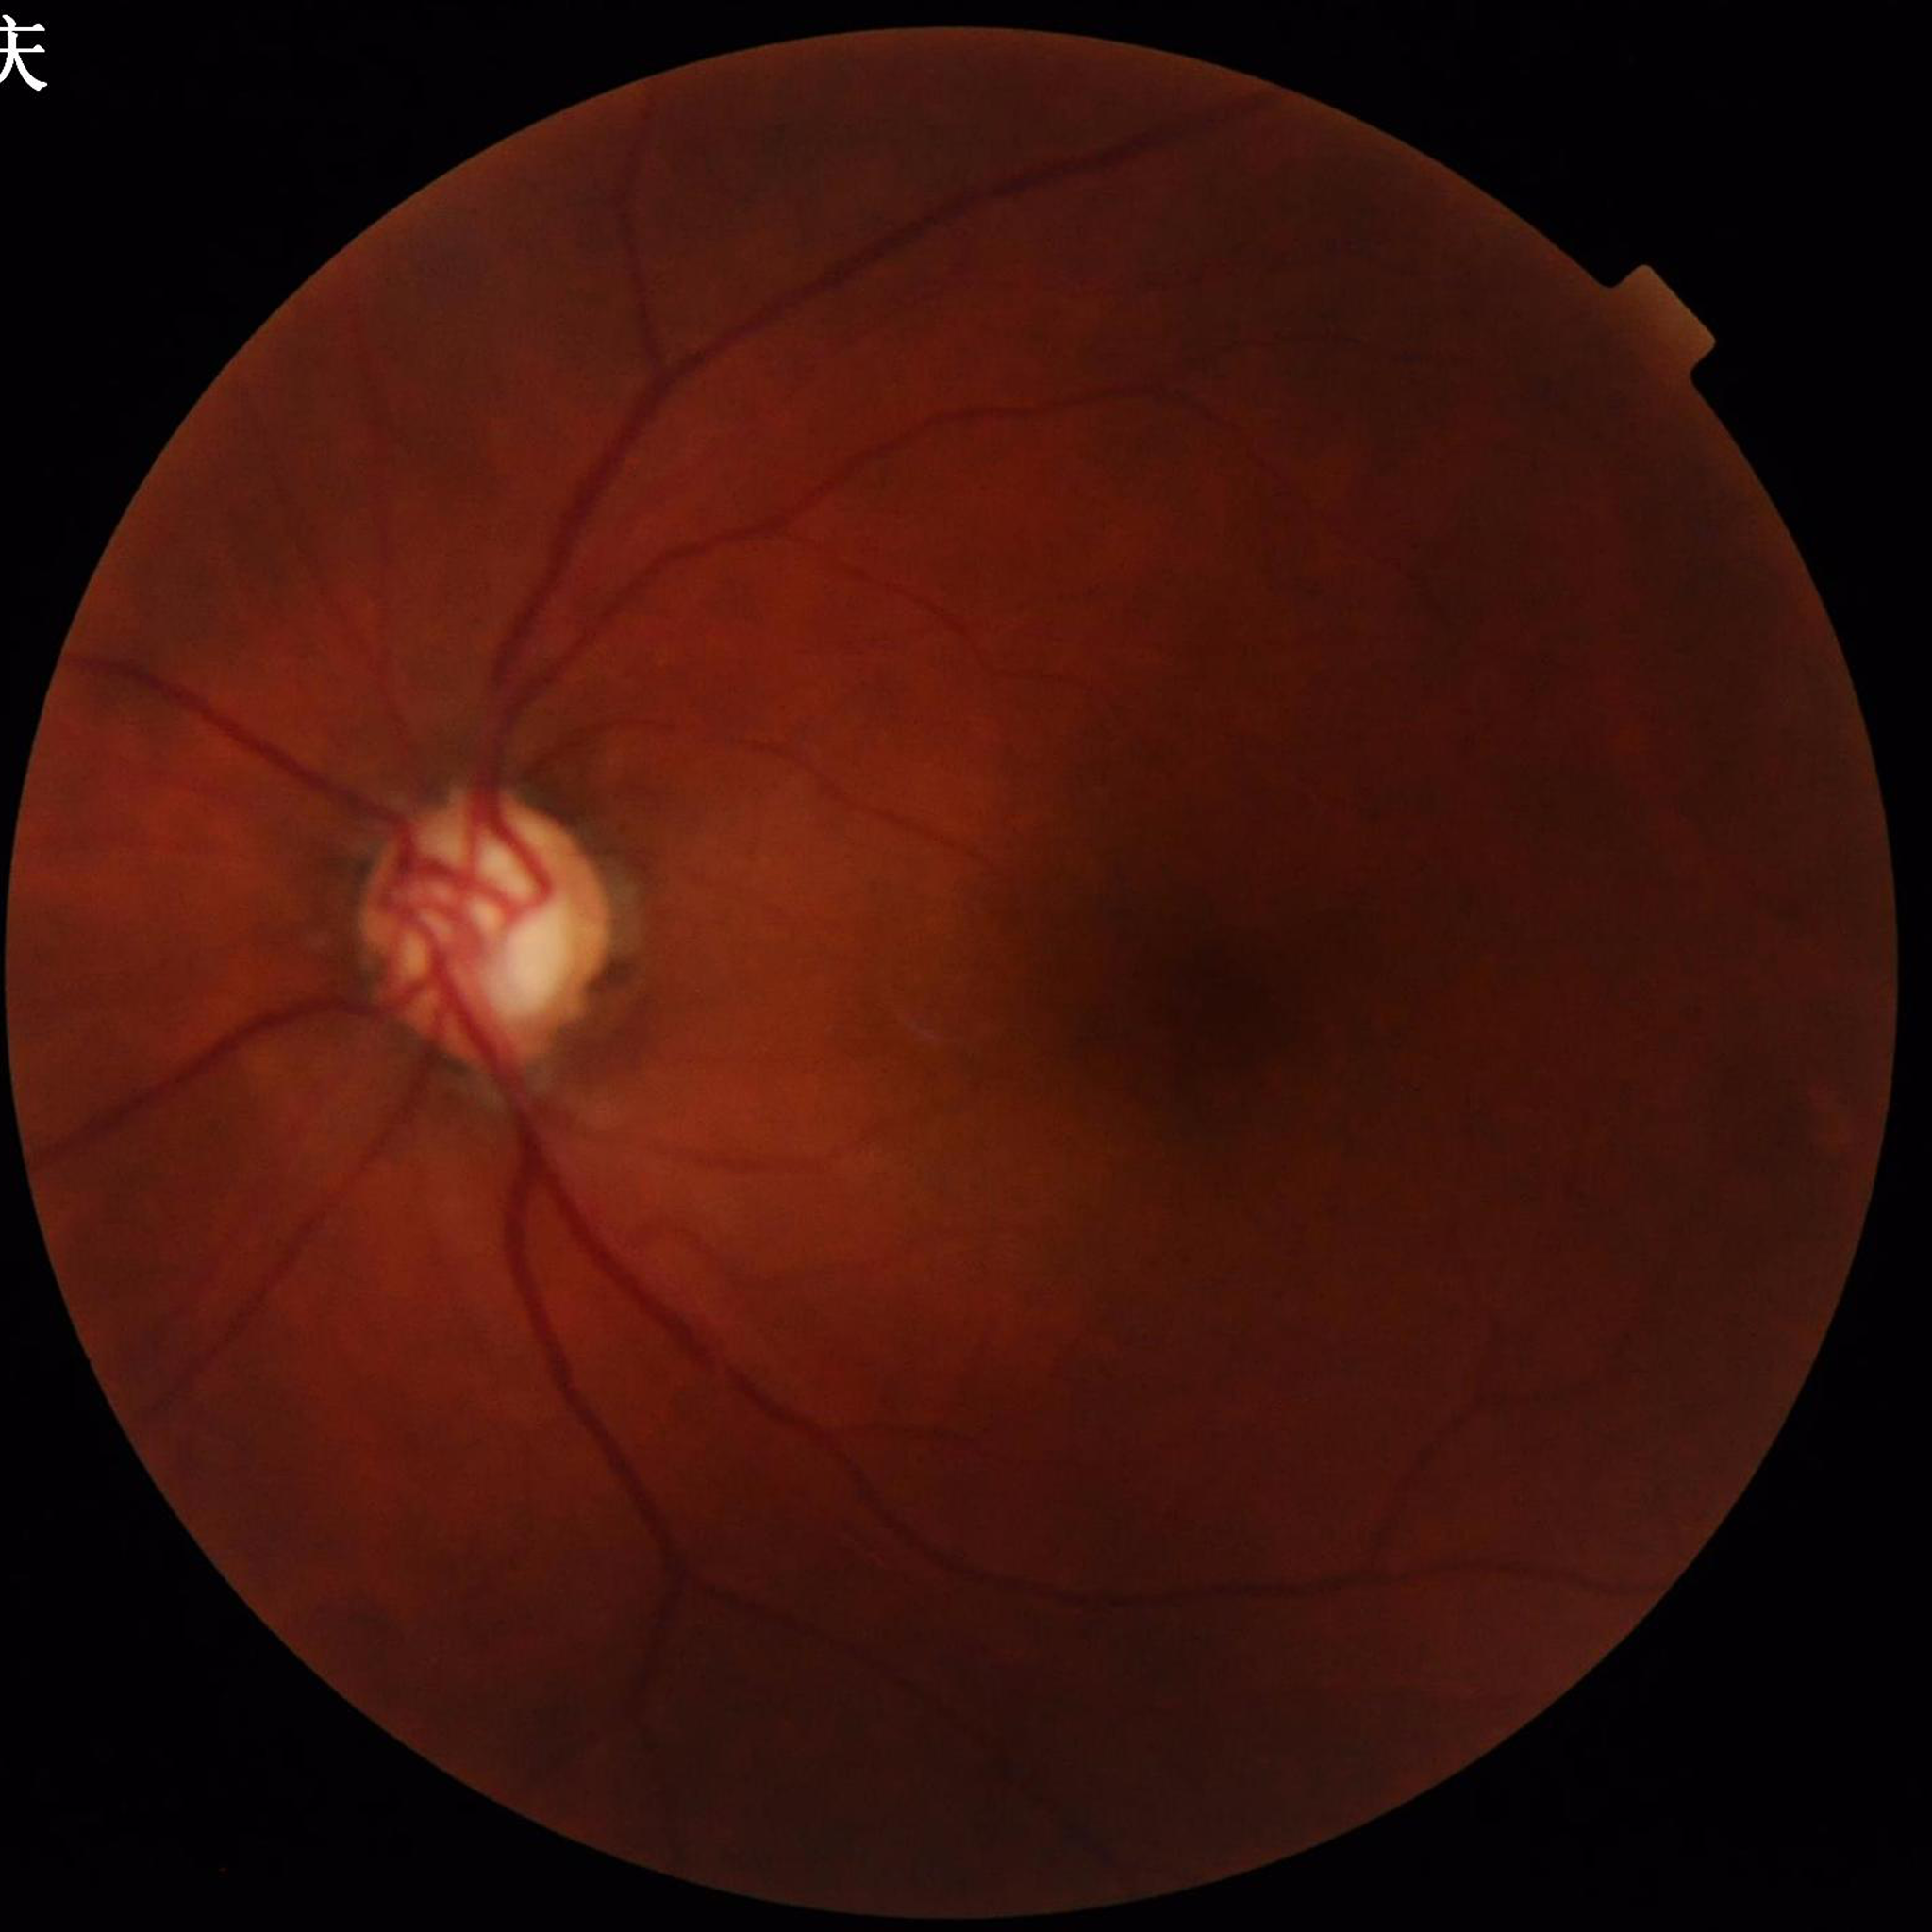
The patient was diagnosed with glaucoma.